FOV: 45 degrees: 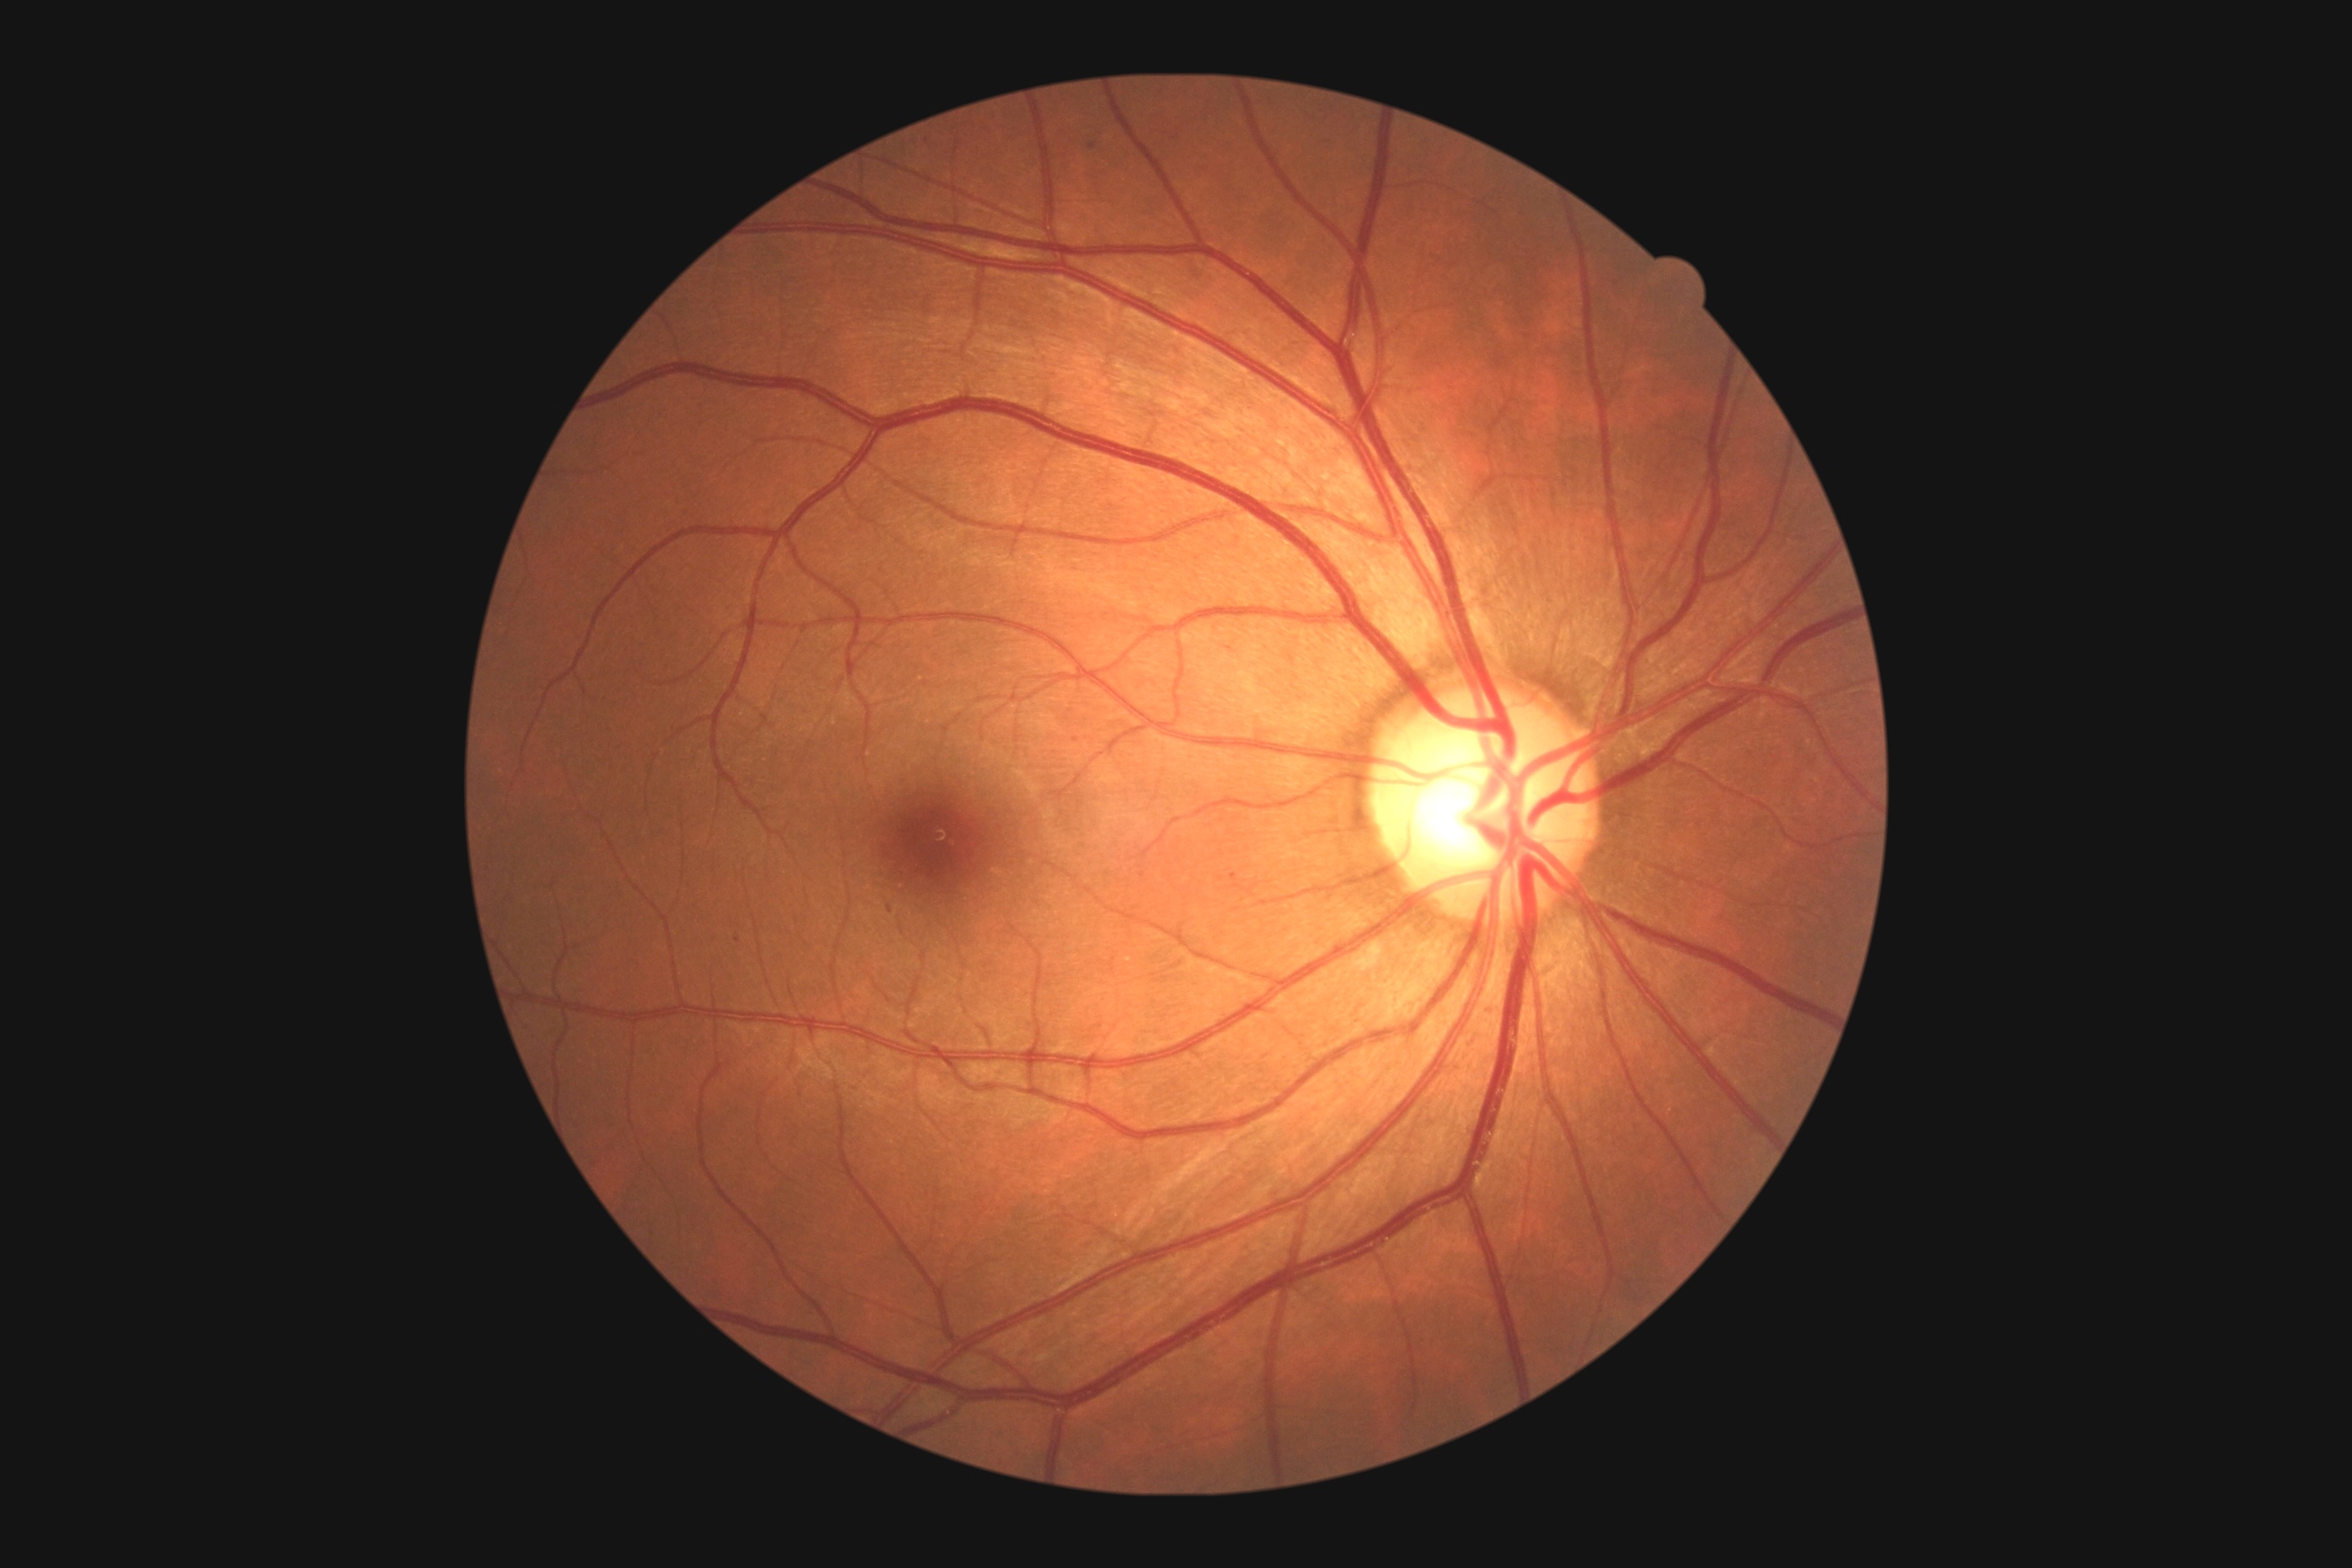
DR severity is grade 2 (moderate NPDR).